Infant wide-field retinal image · 1240x1240 · 100° field of view (Phoenix ICON).
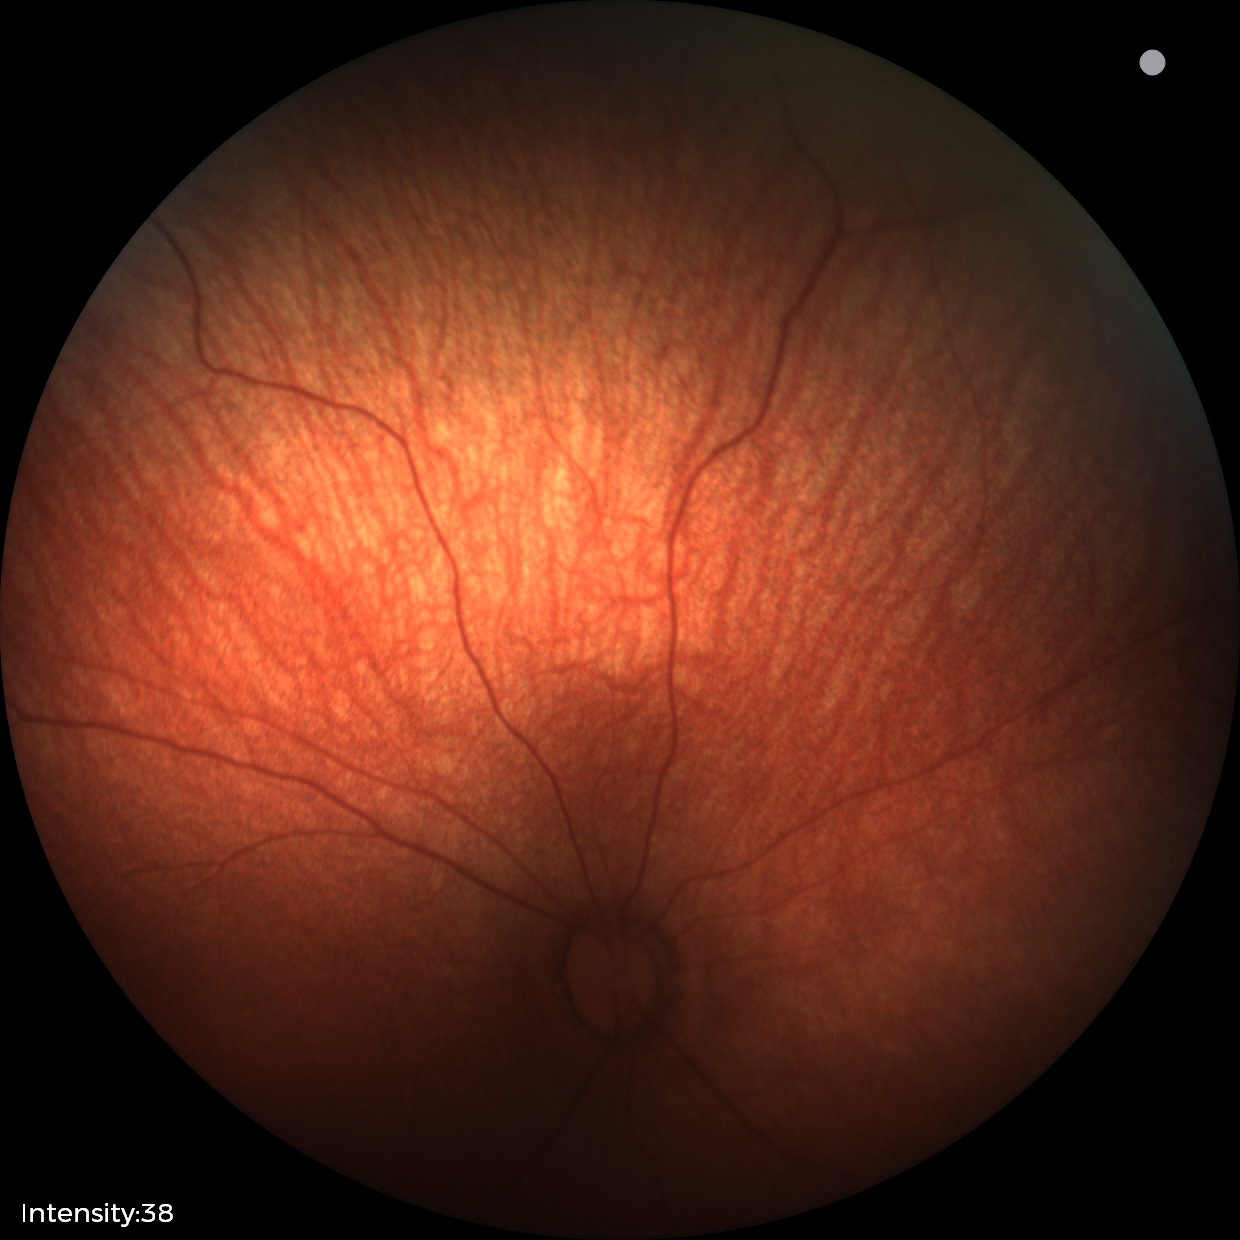

No retinal pathology identified on screening.